Infant wide-field retinal image · image size 1440x1080 — 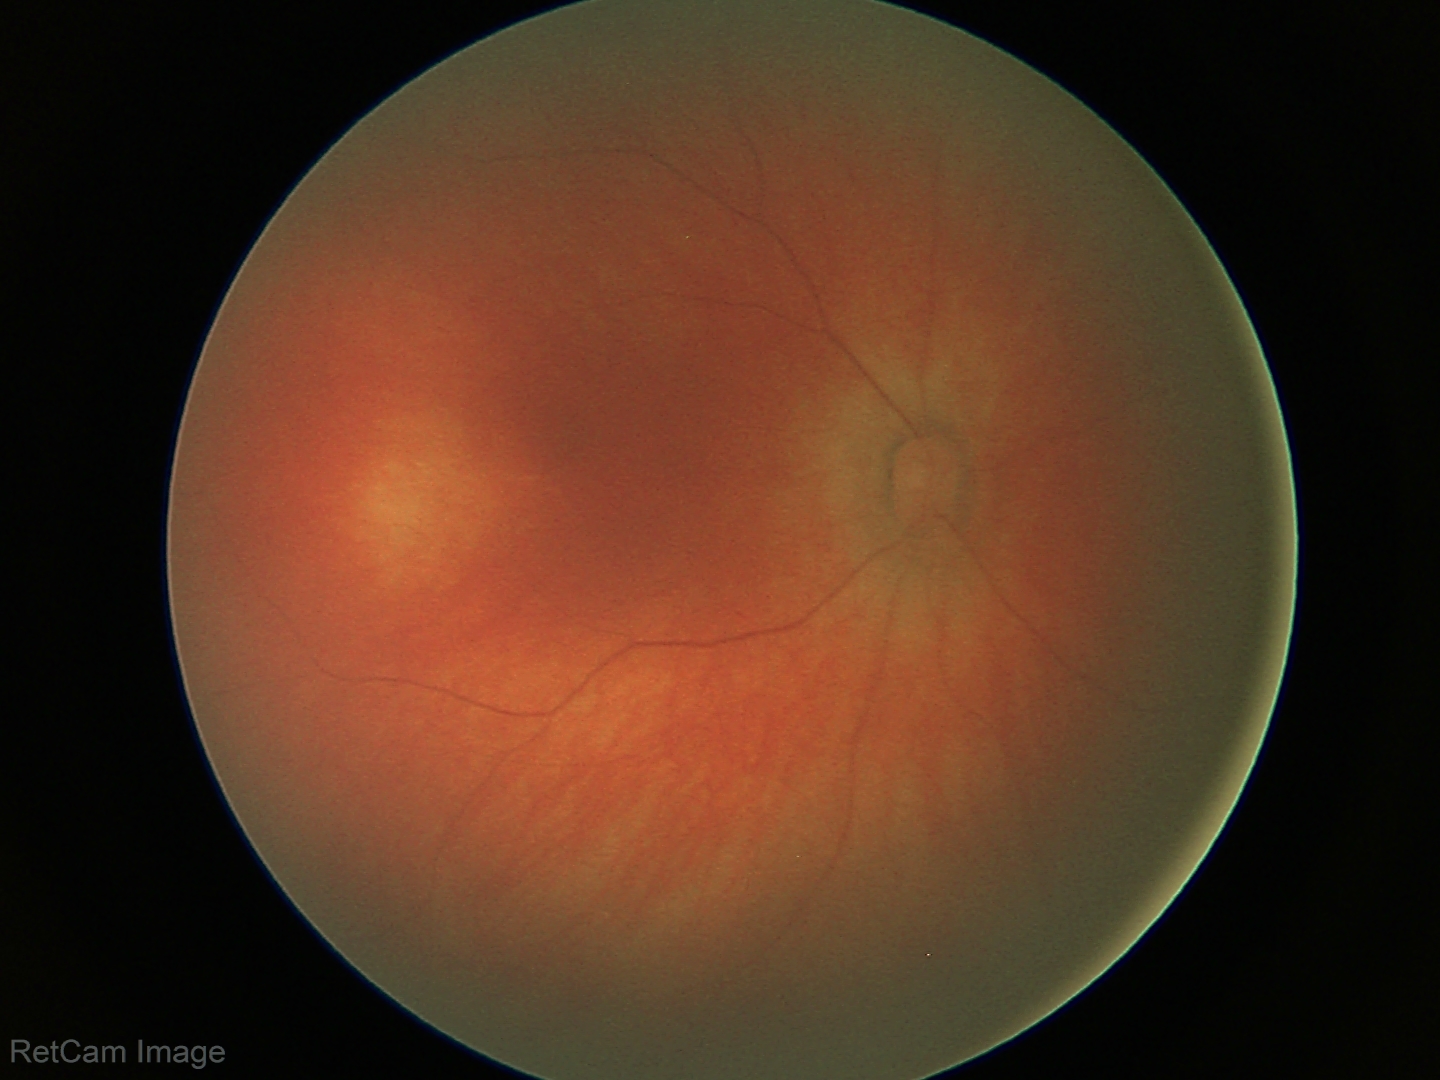 Screening diagnosis = no pathology identified.